Graded on the modified Davis scale, camera: NIDEK AFC-230 — 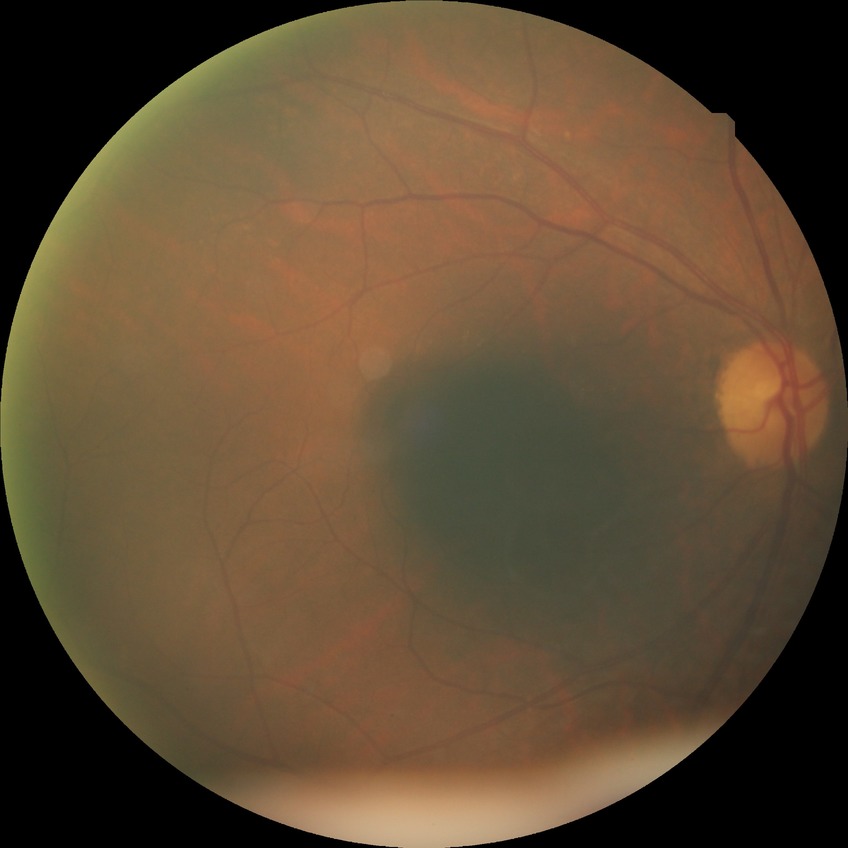

Diabetic retinopathy severity: no diabetic retinopathy.